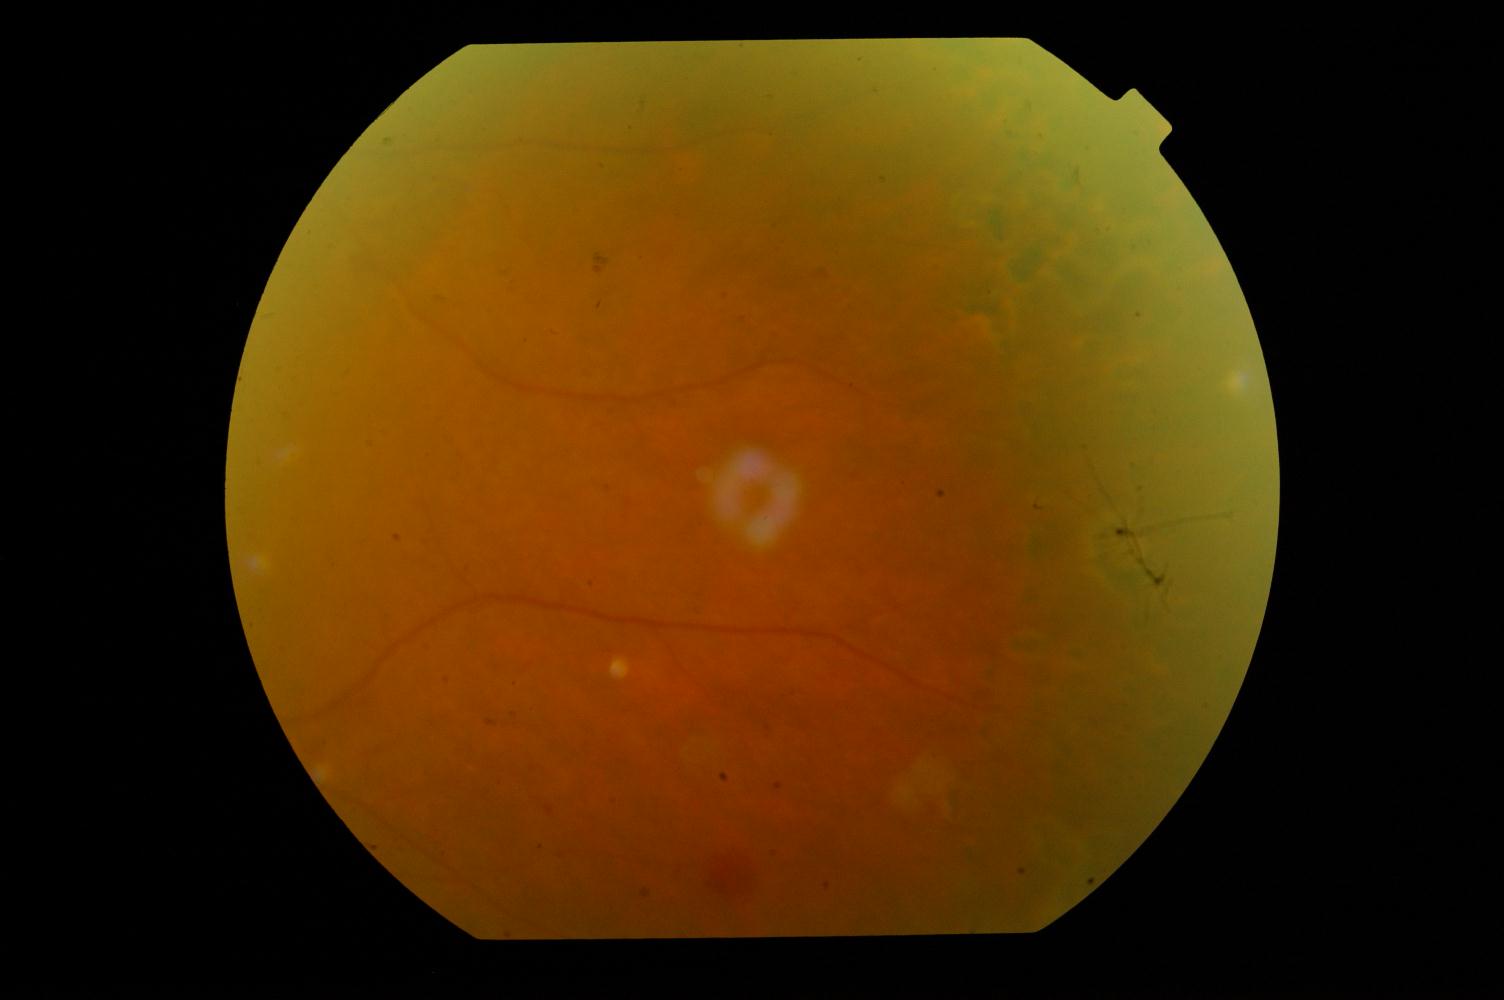 Showing diabetic retinopathy (DR).